Mydriatic (tropicamide phenylephrine 1.0%), Topcon TRC-NW8, 50-degree field of view.
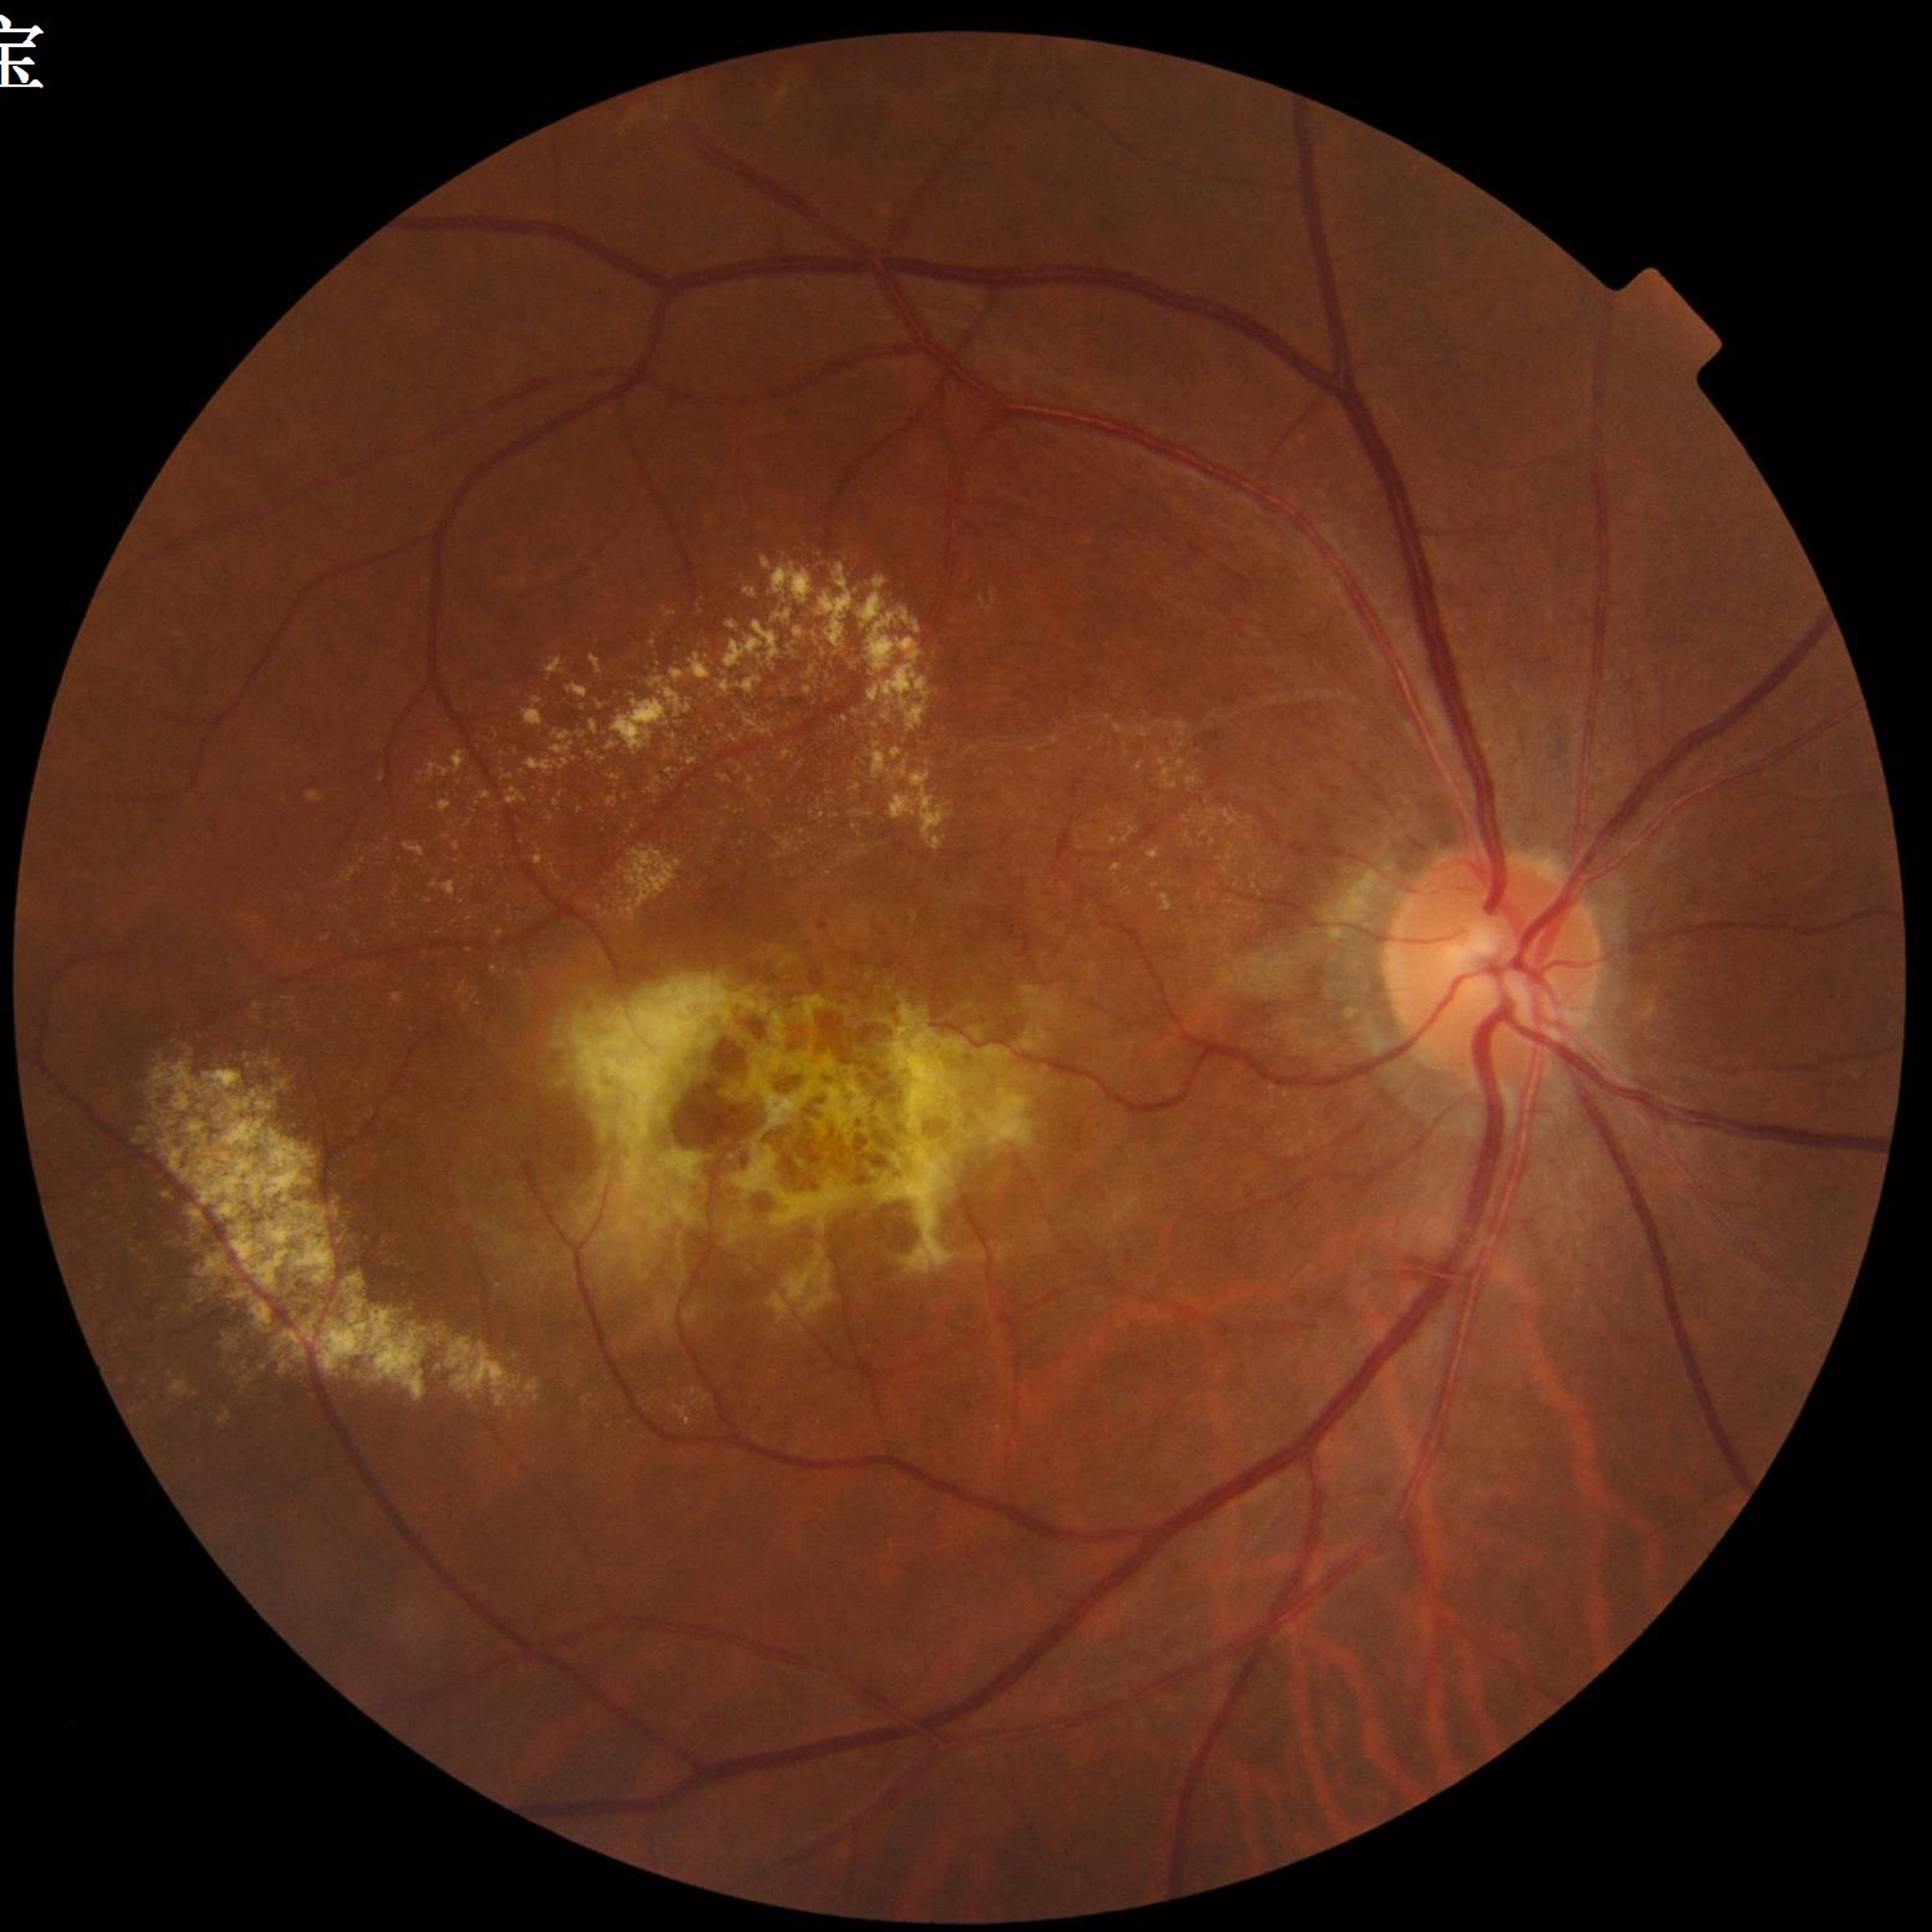

Impression: age-related macular degeneration (AMD)
Quality: adequate